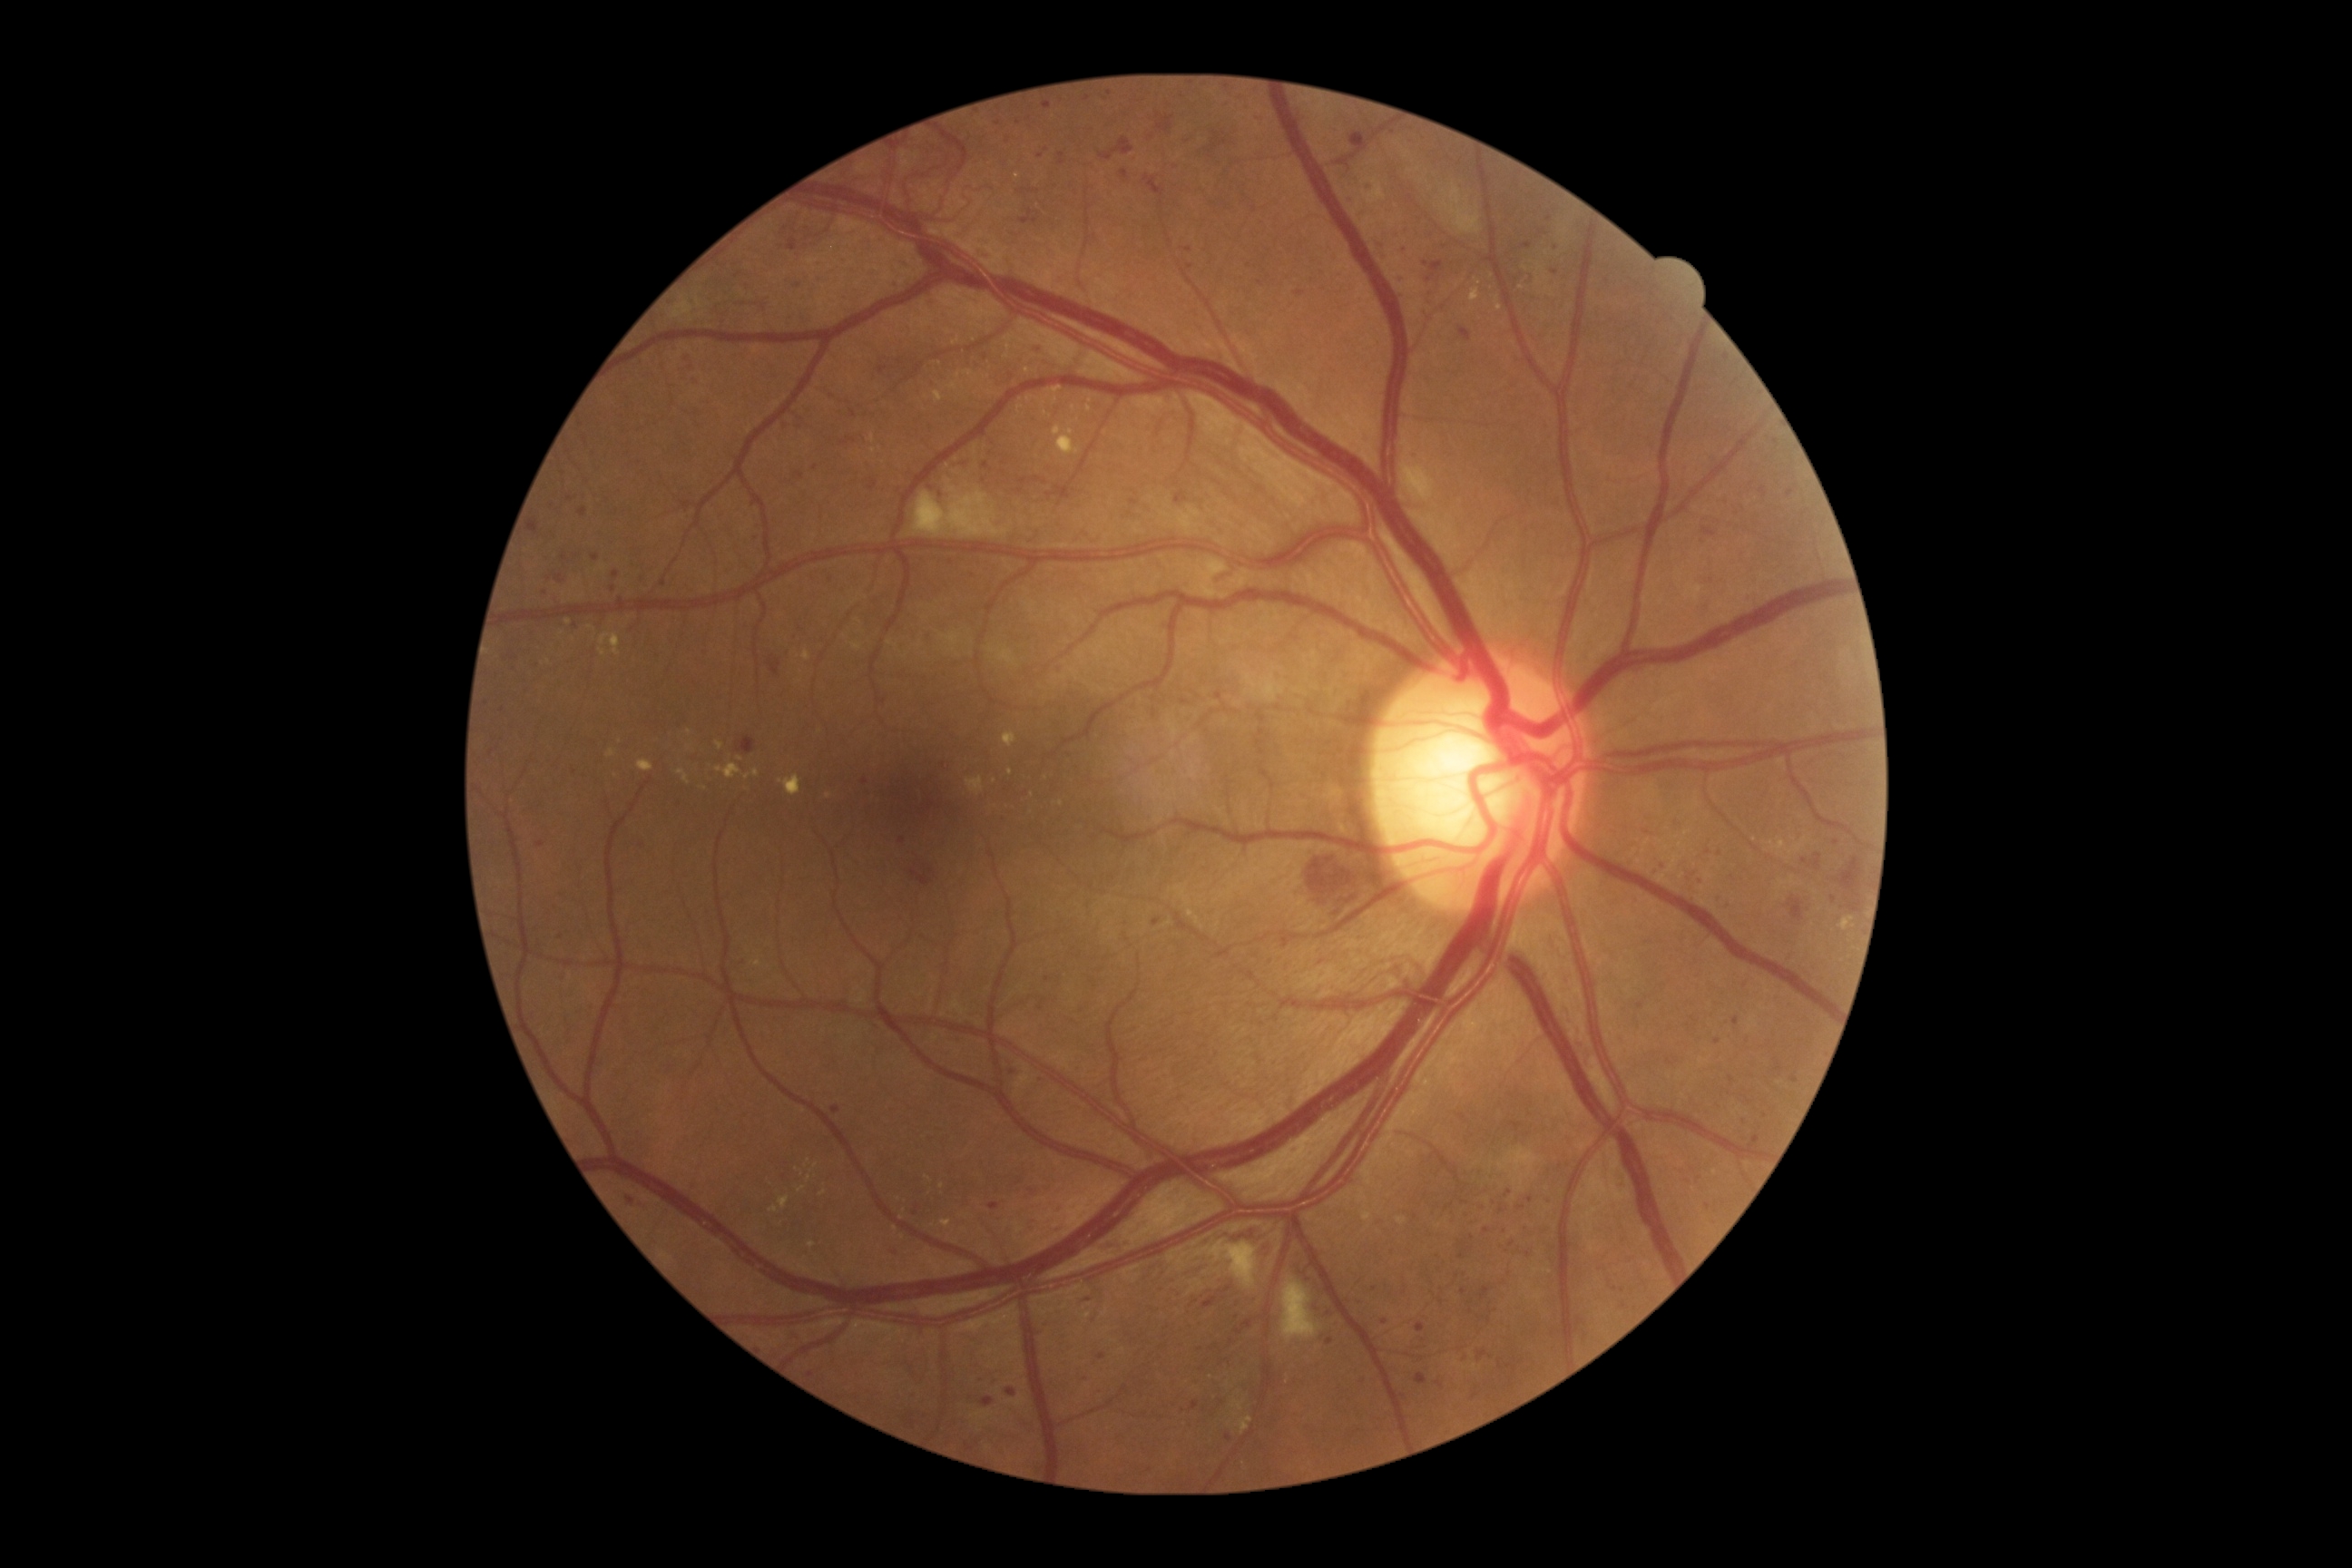 DR grade: severe NPDR (3)
Representative lesions:
MAs (more not shown): 1326:1309:1333:1317 | 1482:1286:1491:1302 | 1293:1146:1302:1152 | 1152:919:1161:926 | 531:520:540:534 | 1358:1298:1364:1309 | 1776:1059:1783:1072 | 1191:1400:1200:1411 | 1507:1364:1518:1371
Small MAs near (1375, 1288) | (999, 124) | (1047, 150) | (1228, 1438) | (1543, 234) | (679, 802) | (800, 427) | (1766, 1116) | (1473, 1238) | (1550, 219)